Image size 512x512, fundus photo:
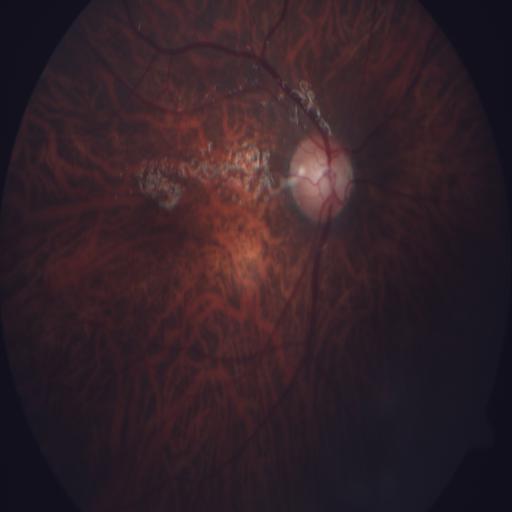

Diagnoses: optic disc cupping (ODC); tessellation (TSLN).